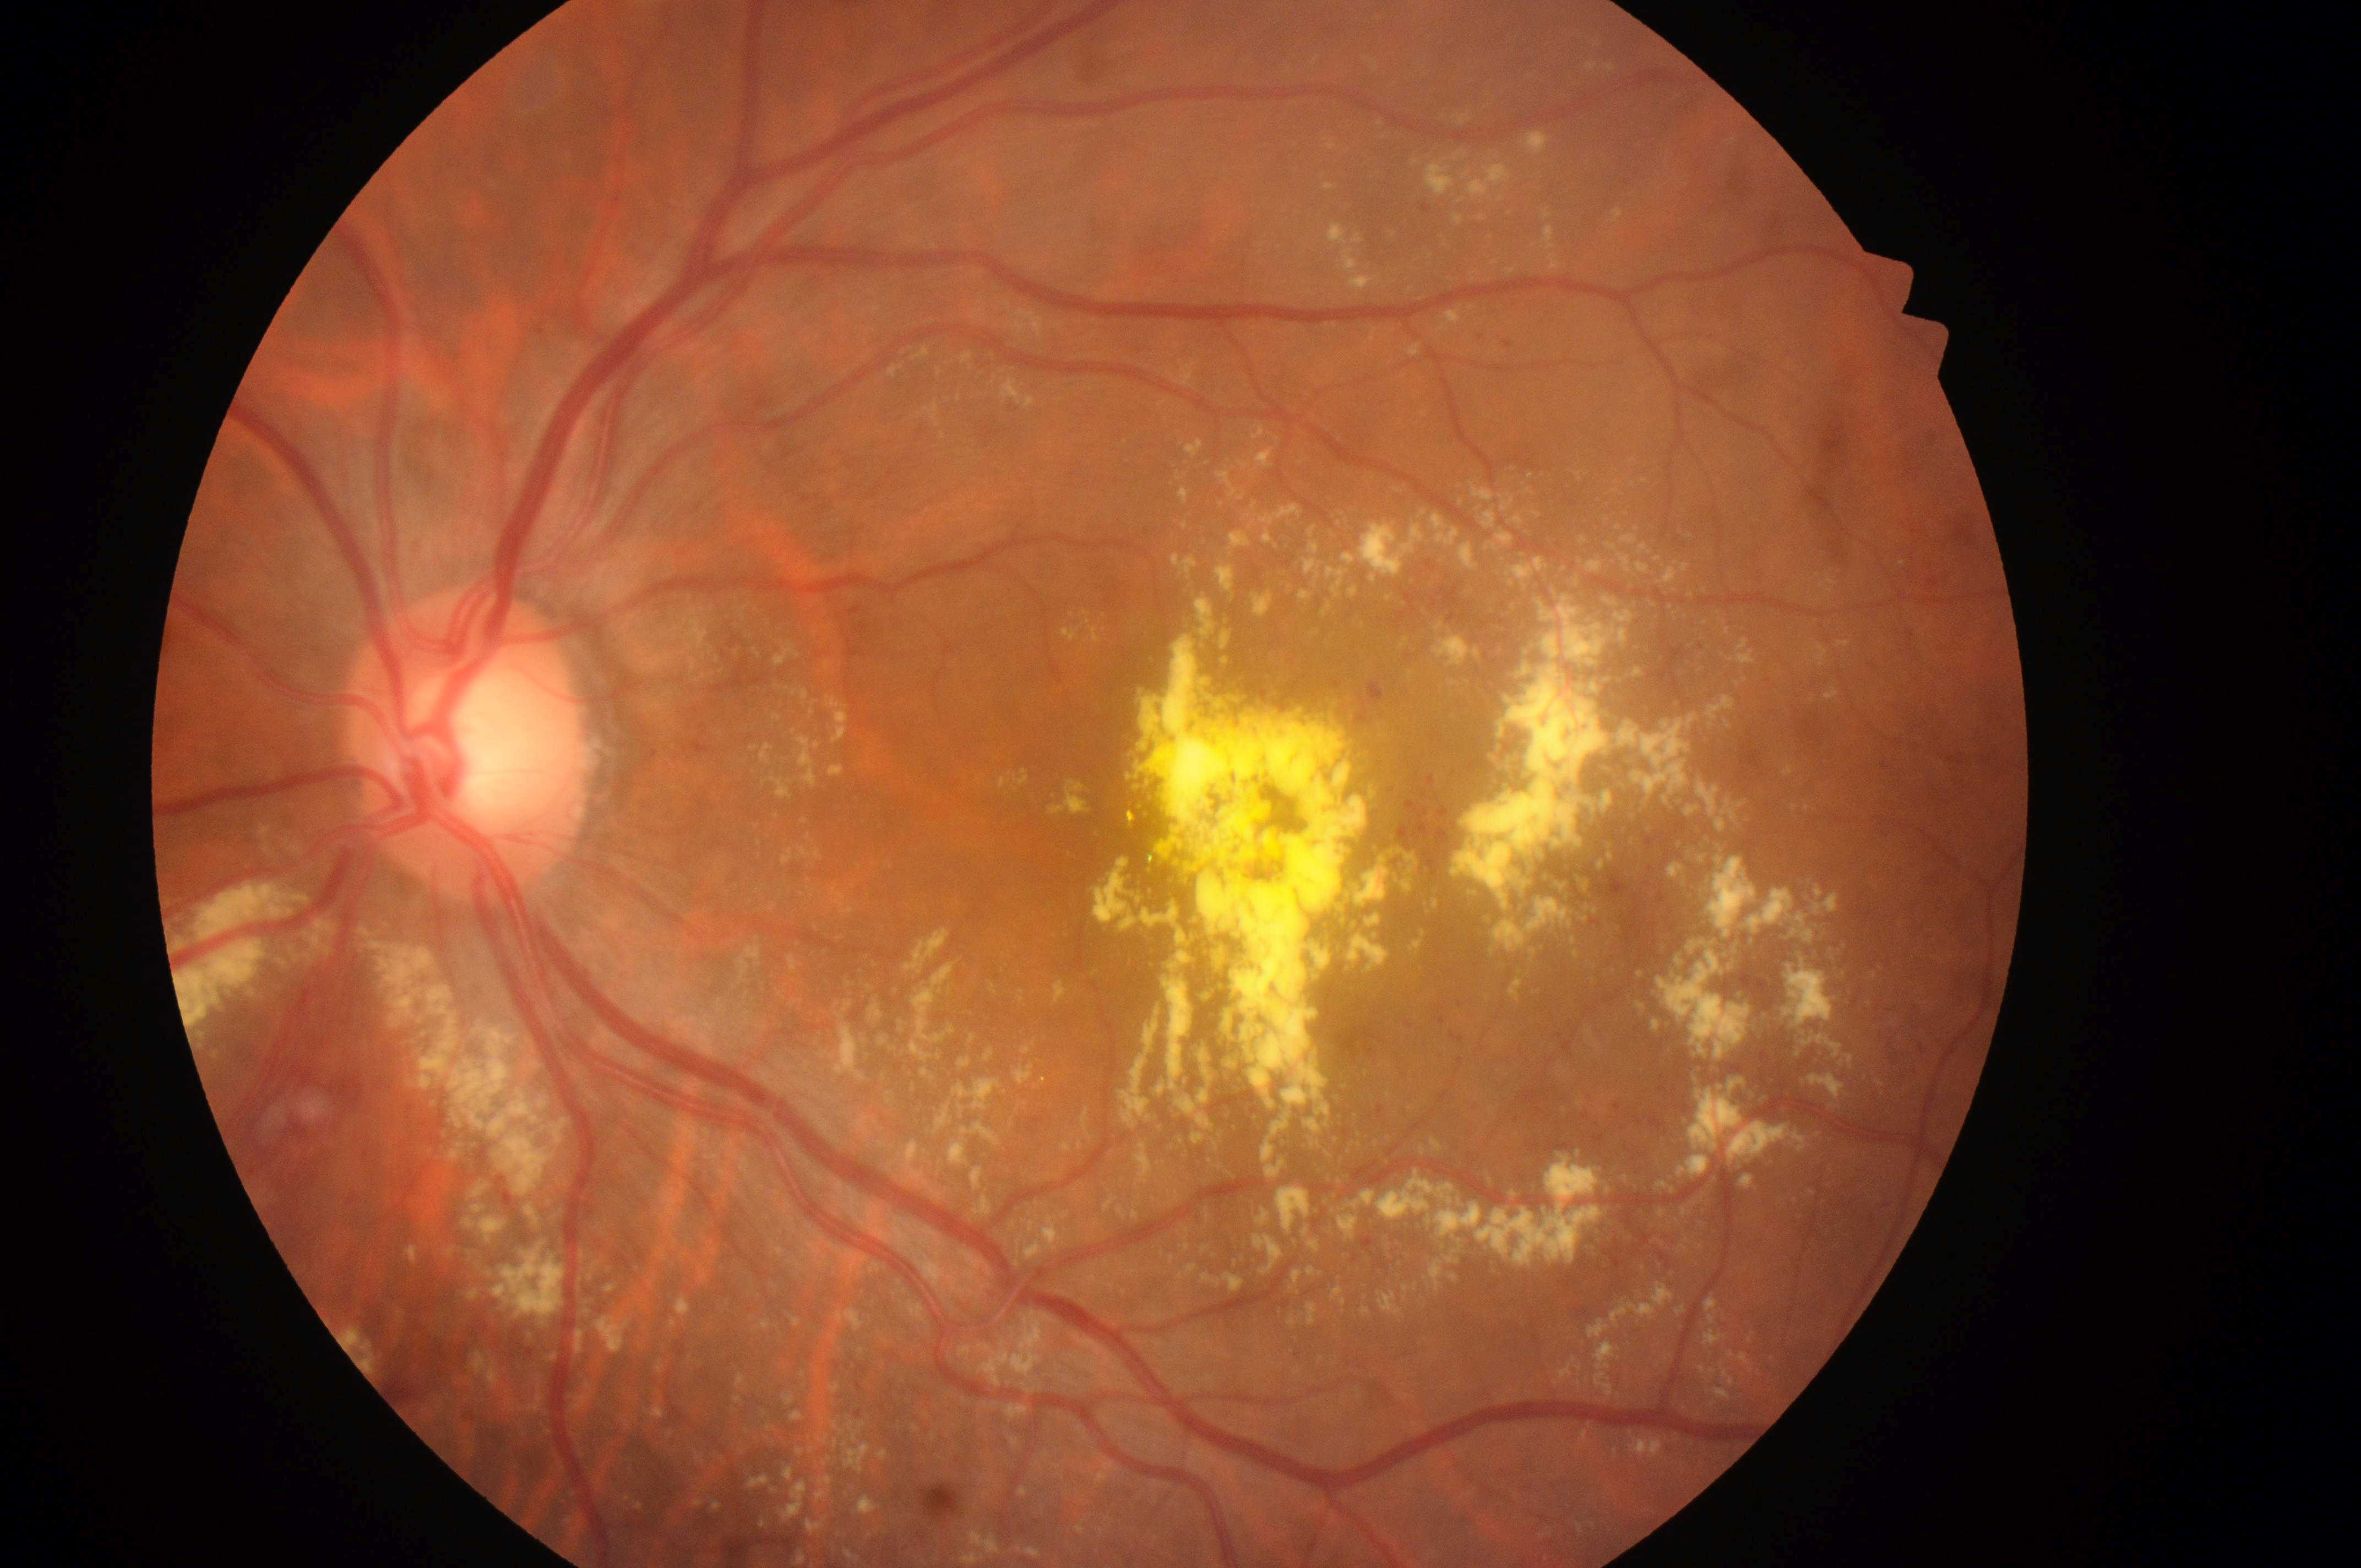
The fovea is at (x: 1209, y: 847). DR grade is moderate NPDR (2). The ONH is at (x: 468, y: 760). The image shows the left eye. DME risk is grade 2 (high risk).